1240x1240px; acquired on the Phoenix ICON; infant wide-field fundus photograph: 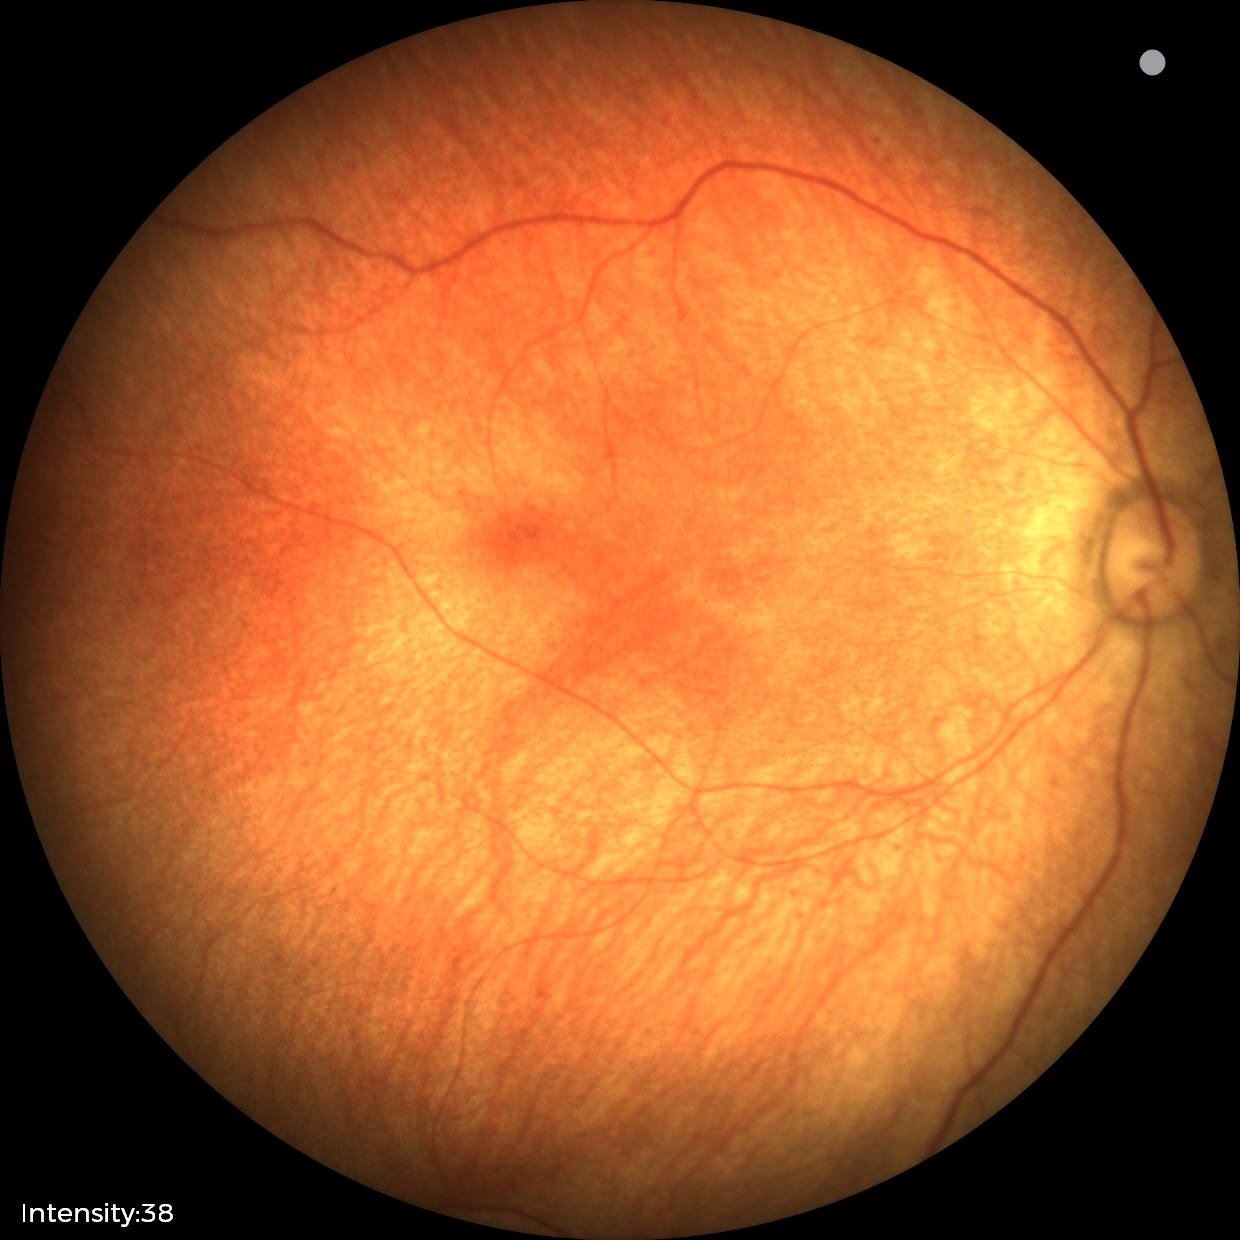

Physiological retinal appearance for postconceptual age.